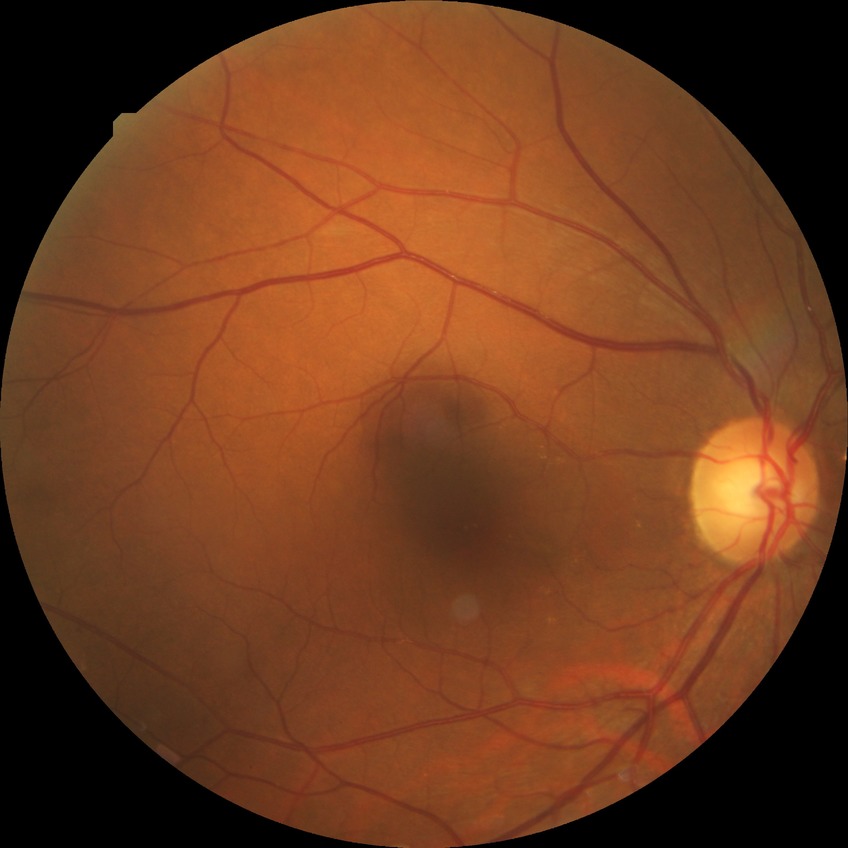
diabetic retinopathy (DR): no diabetic retinopathy (NDR).